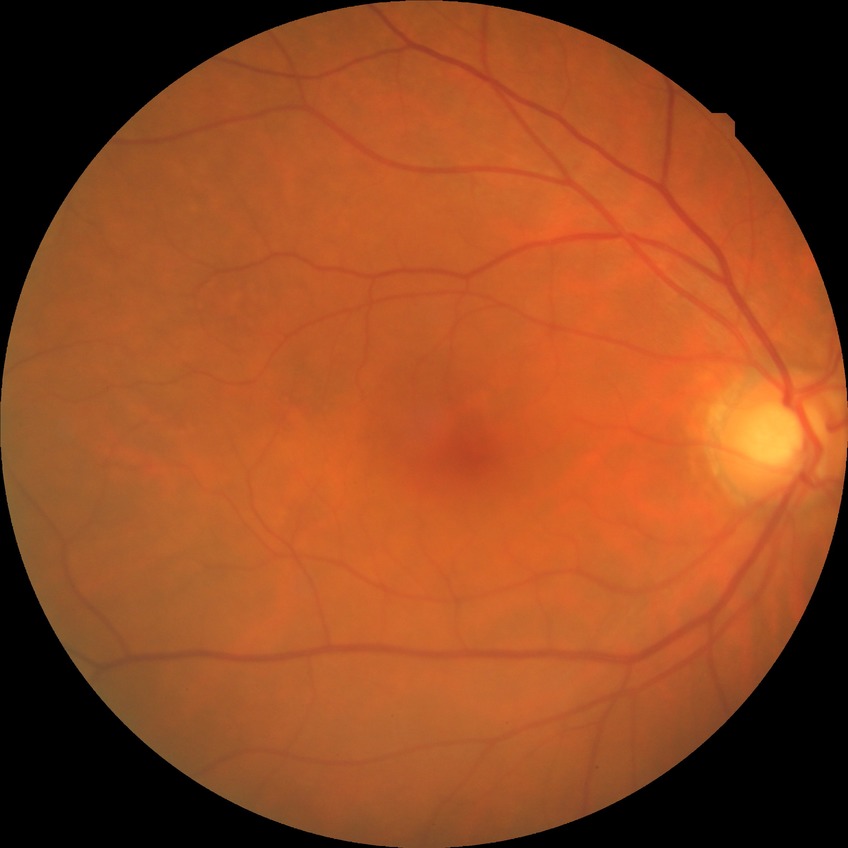 Davis grading = no diabetic retinopathy.